Modified Davis grading:
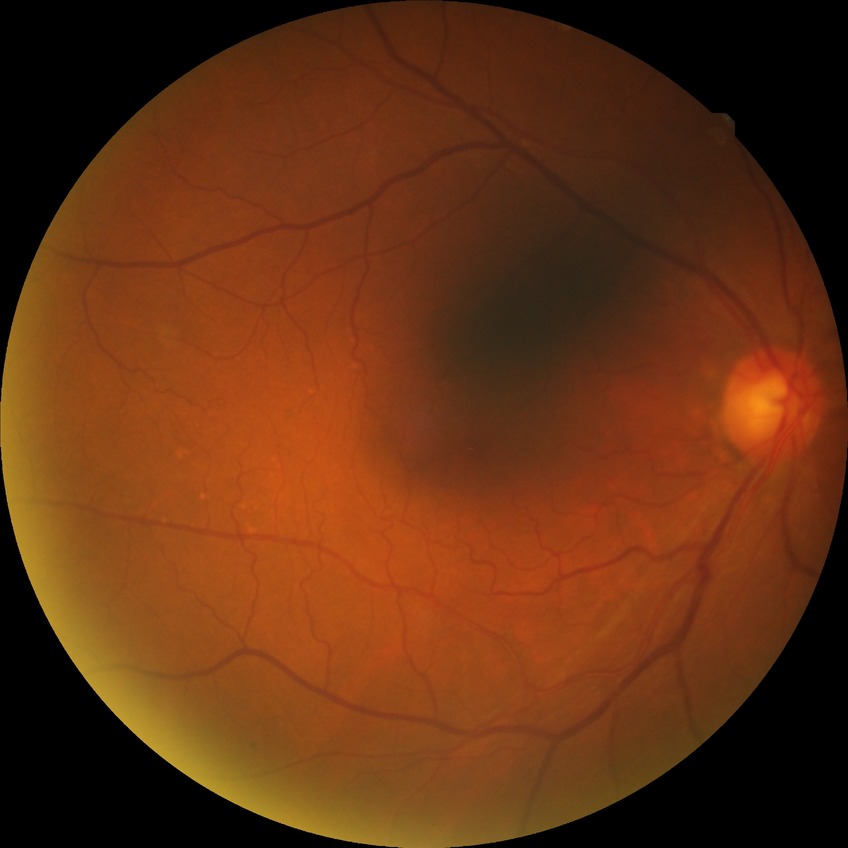

Diabetic retinopathy (DR): NDR (no diabetic retinopathy).